CFP. 848x848px. 45 degree fundus photograph — 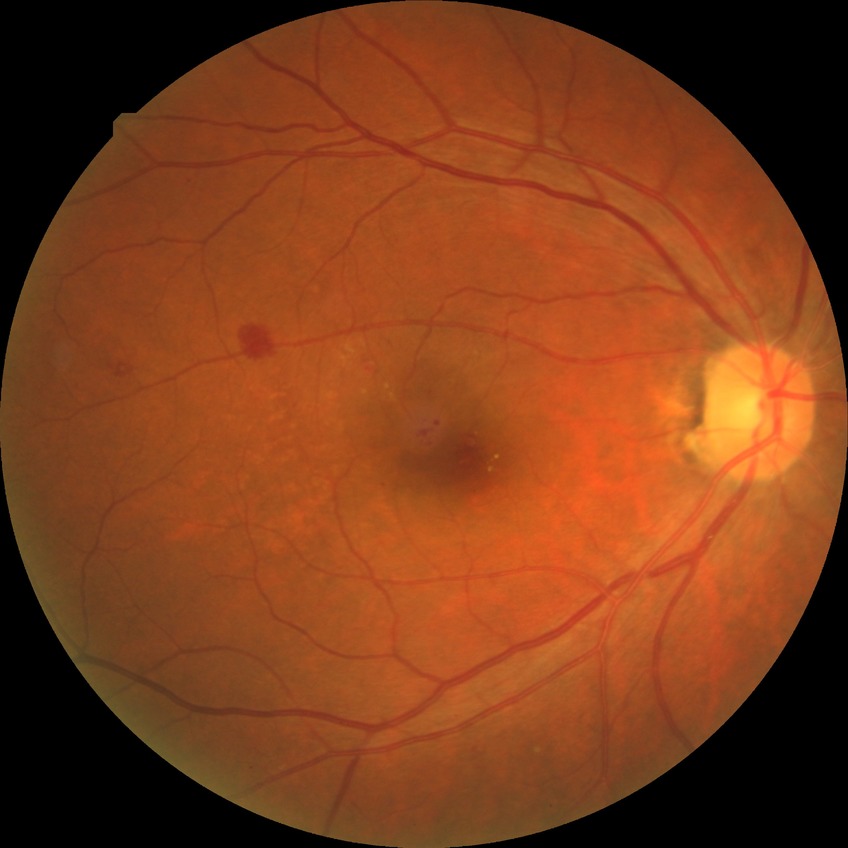
– Davis stage: SDR